Image size 2352x1568. Color fundus photograph. 45° FOV: 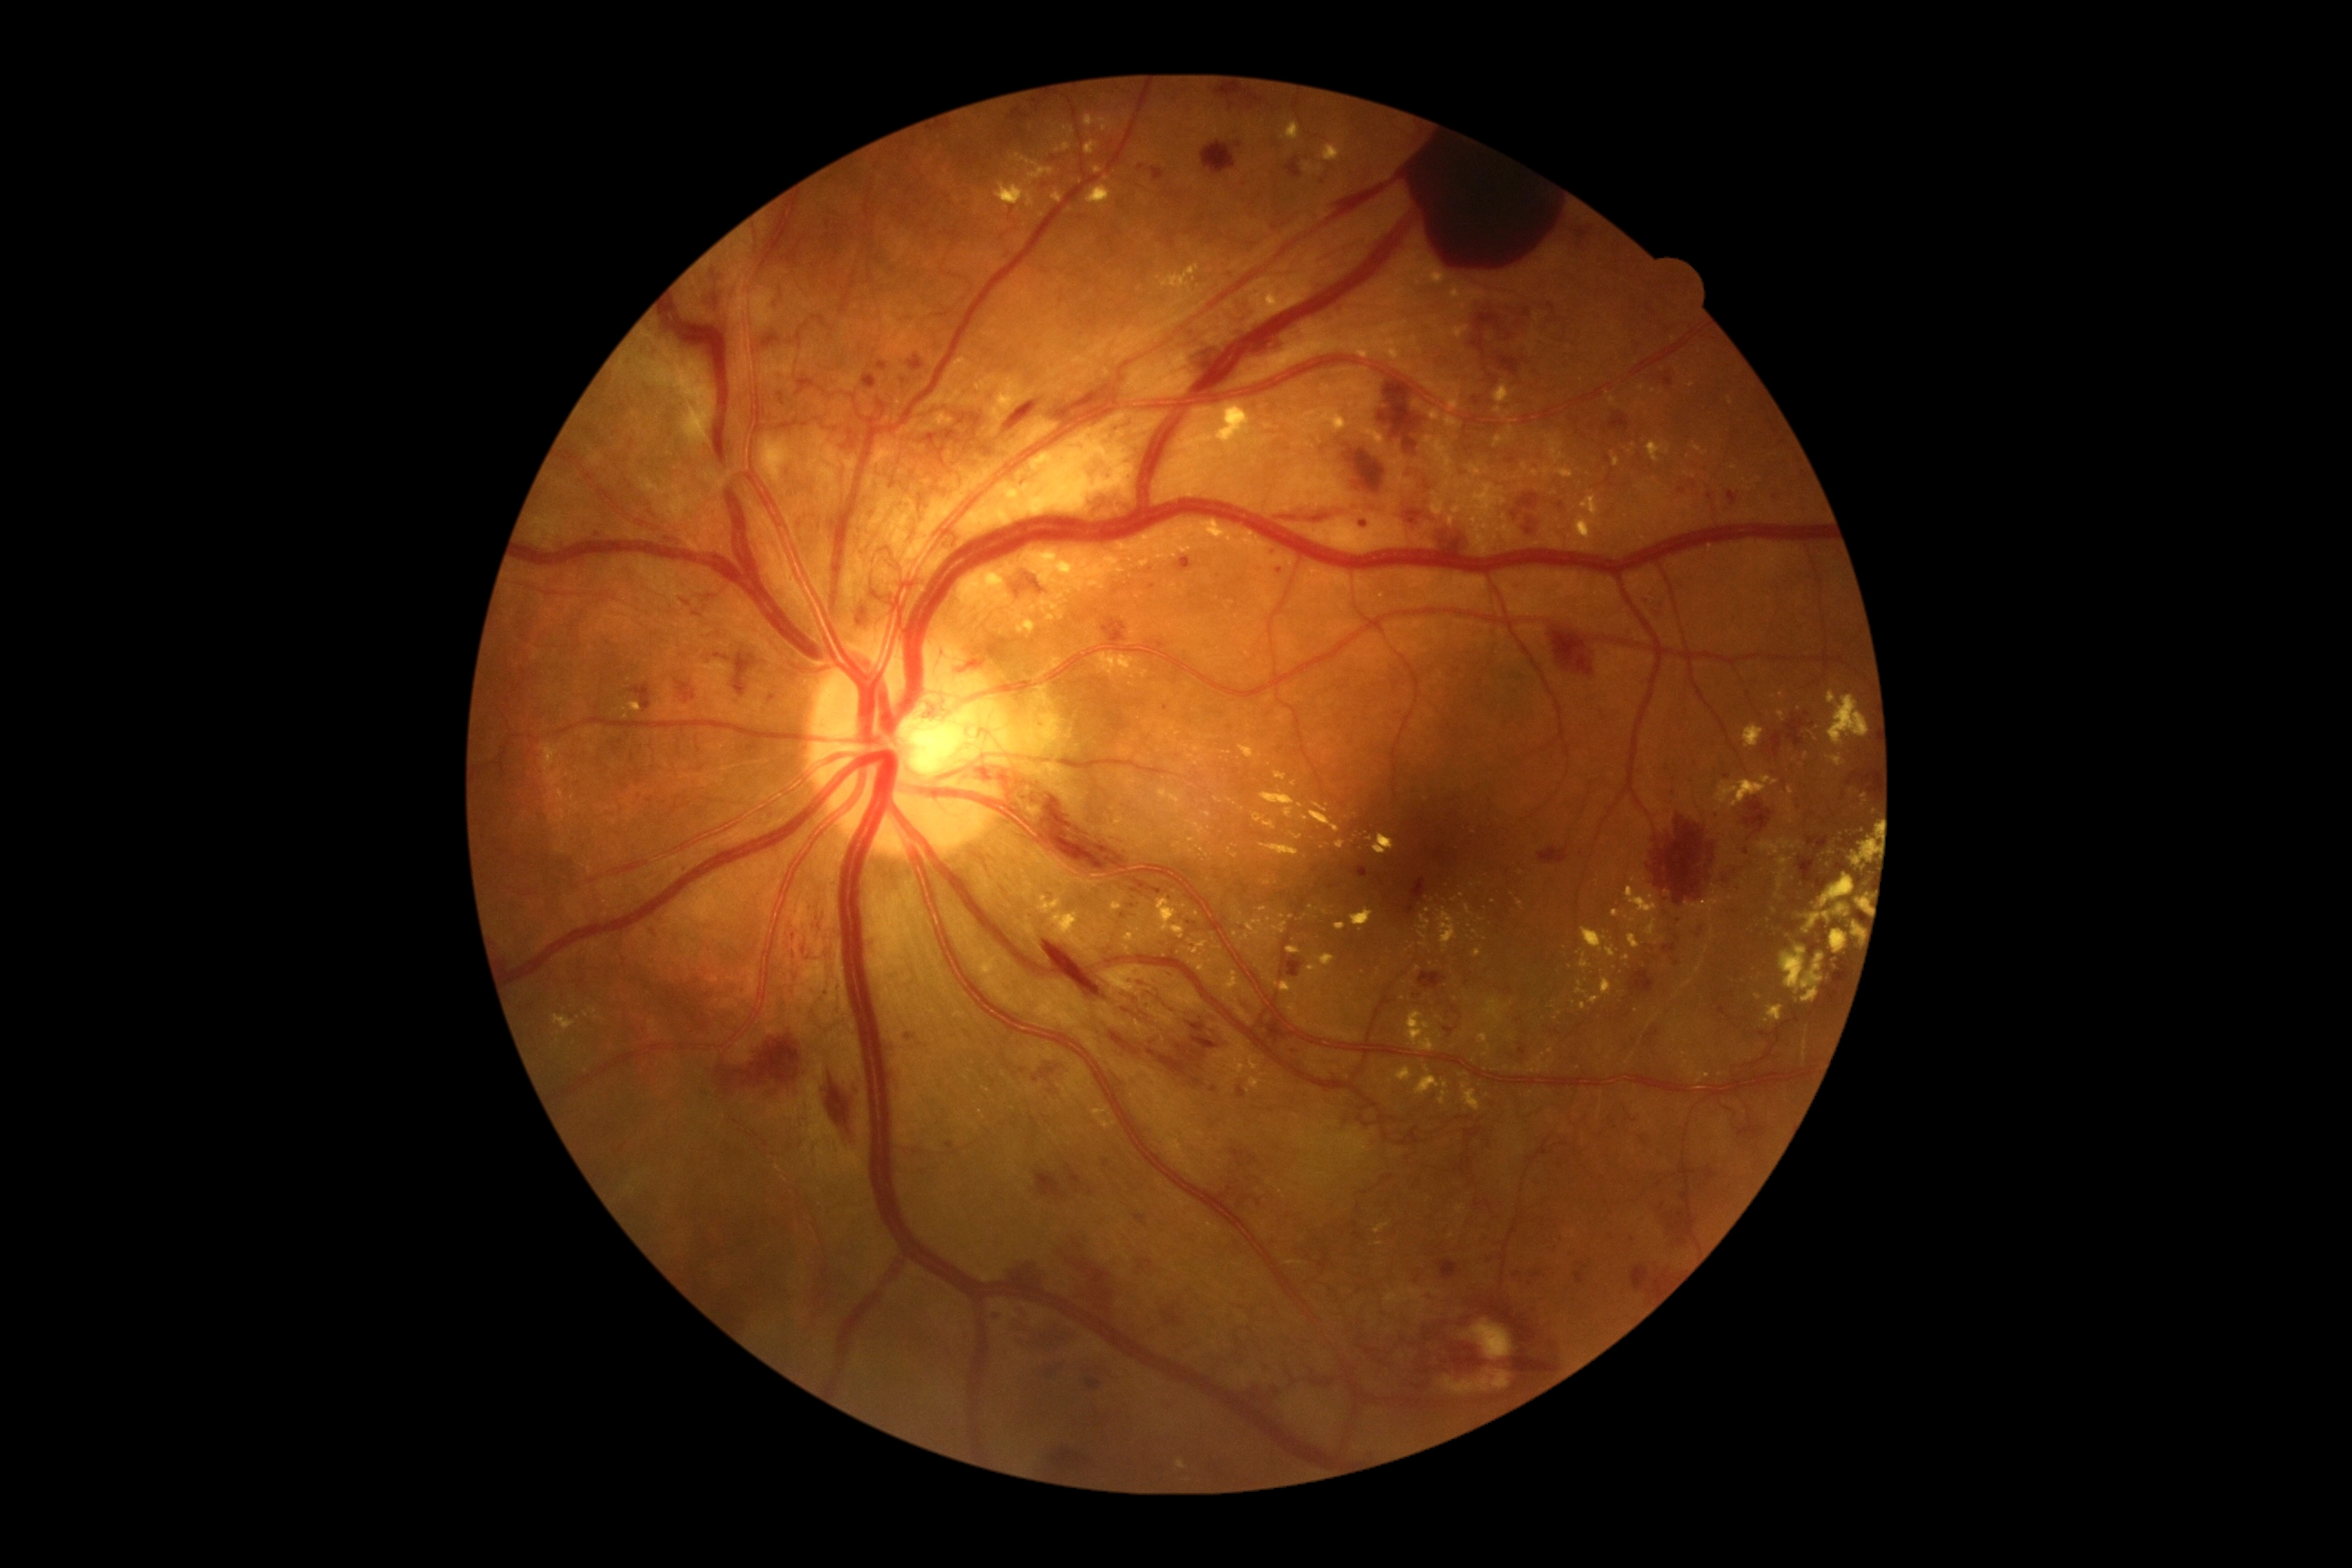 {"partial": true, "dr_grade": 4, "dr_grade_name": "PDR", "lesions": {"ex": [[1260, 1073, 1268, 1079], [1395, 230, 1453, 288], [1322, 144, 1342, 162], [1473, 930, 1480, 939], [1420, 916, 1431, 930], [1173, 843, 1182, 848], [1275, 772, 1288, 781], [1235, 908, 1288, 941], [1041, 600, 1064, 620], [1582, 928, 1607, 952], [1778, 710, 1787, 721], [1602, 977, 1612, 995], [1153, 533, 1193, 560]], "ex_small_centers": [[1389, 1081], [1705, 454], [1174, 741], [1758, 998], [586, 1014], [1162, 725]], "he": [[761, 692, 781, 707], [676, 681, 696, 703], [1400, 1286, 1556, 1406], [1769, 491, 1783, 507], [1531, 1271, 1542, 1279], [1286, 956, 1308, 981], [1527, 516, 1534, 525], [716, 654, 730, 662], [1769, 937, 1772, 945], [1081, 1364, 1128, 1395], [1237, 1086, 1248, 1099], [754, 331, 803, 353], [1435, 531, 1469, 554], [1696, 923, 1707, 939], [1242, 1197, 1251, 1202], [1273, 505, 1386, 524]], "he_small_centers": [[1846, 693], [598, 534]]}}